Acquired with a NIDEK AFC-230. Color fundus photograph. 45° field of view:
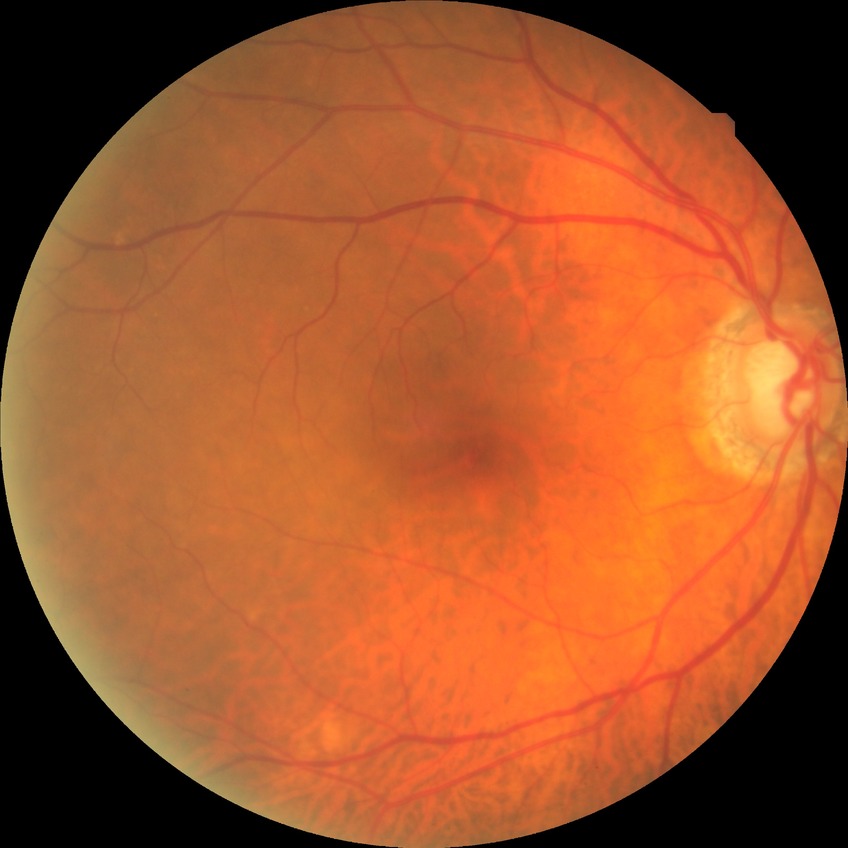

Diabetic retinopathy (DR) is NDR (no diabetic retinopathy).